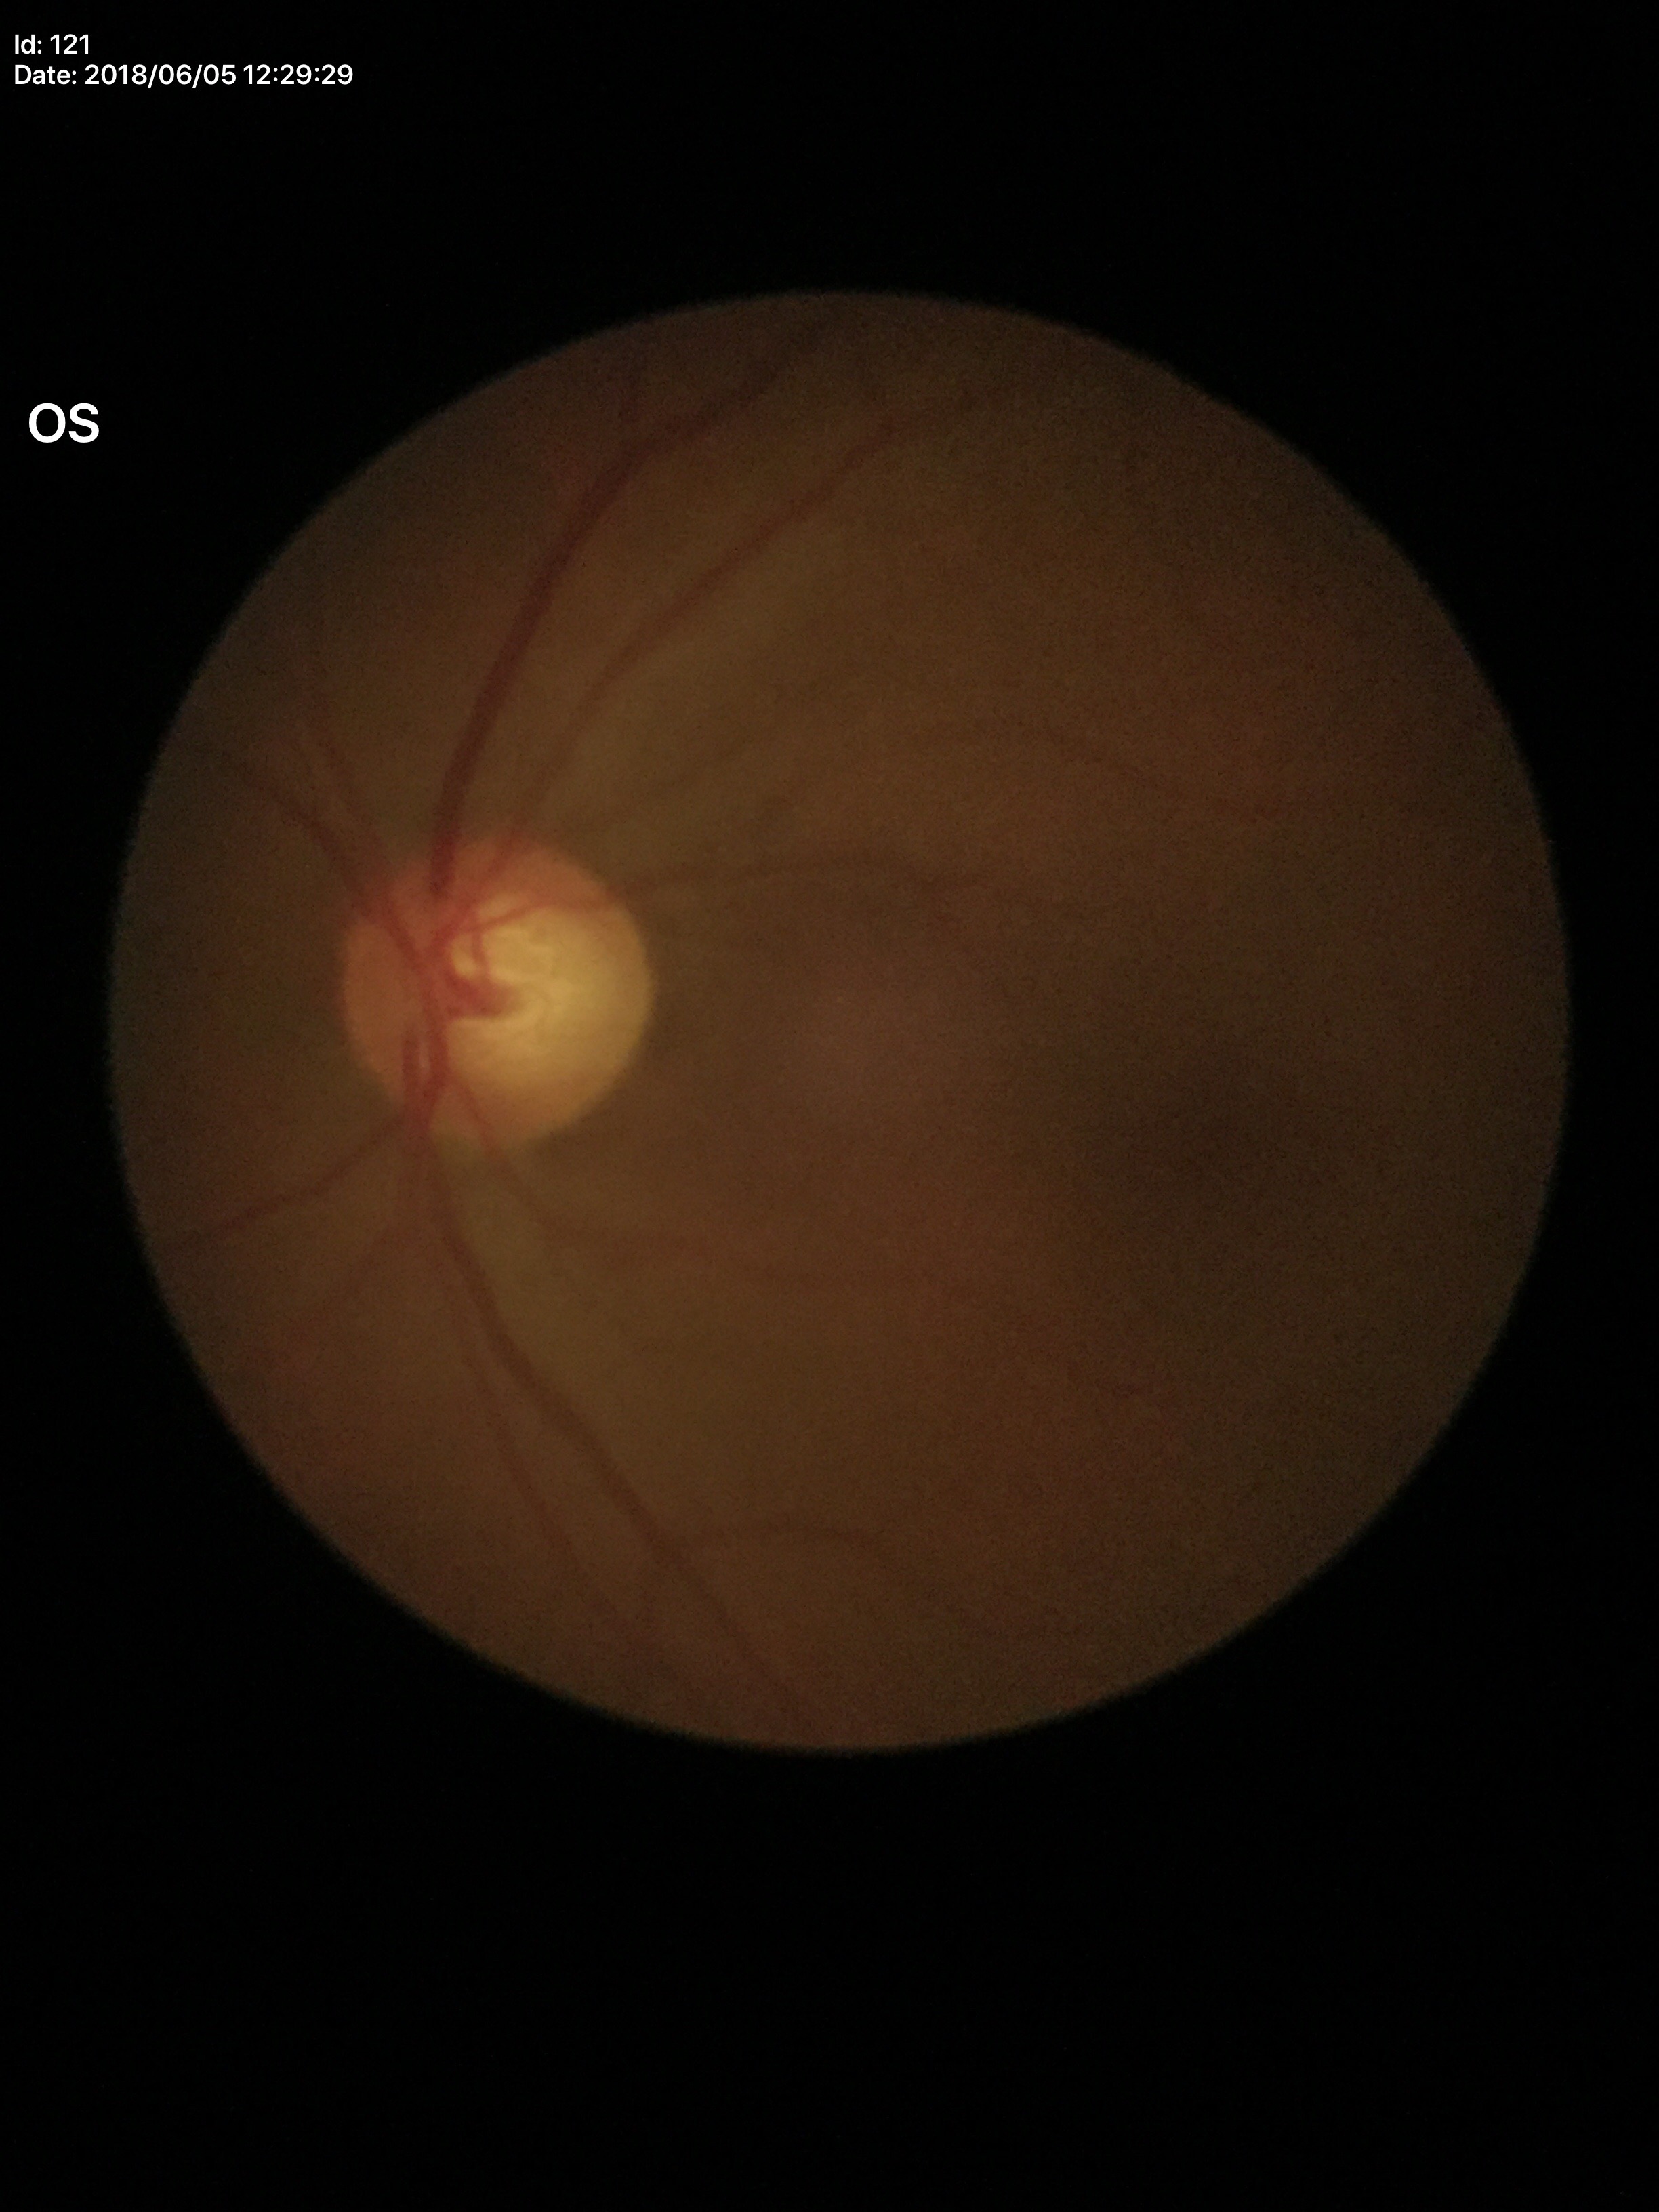
{
  "glaucoma_decision": "suspicious (four of five ophthalmologists flagged glaucoma suspect)",
  "vcdr": "0.65"
}